Centered on the macula · 2361 by 1568 pixels · acquired with a Kowa VX-10α: 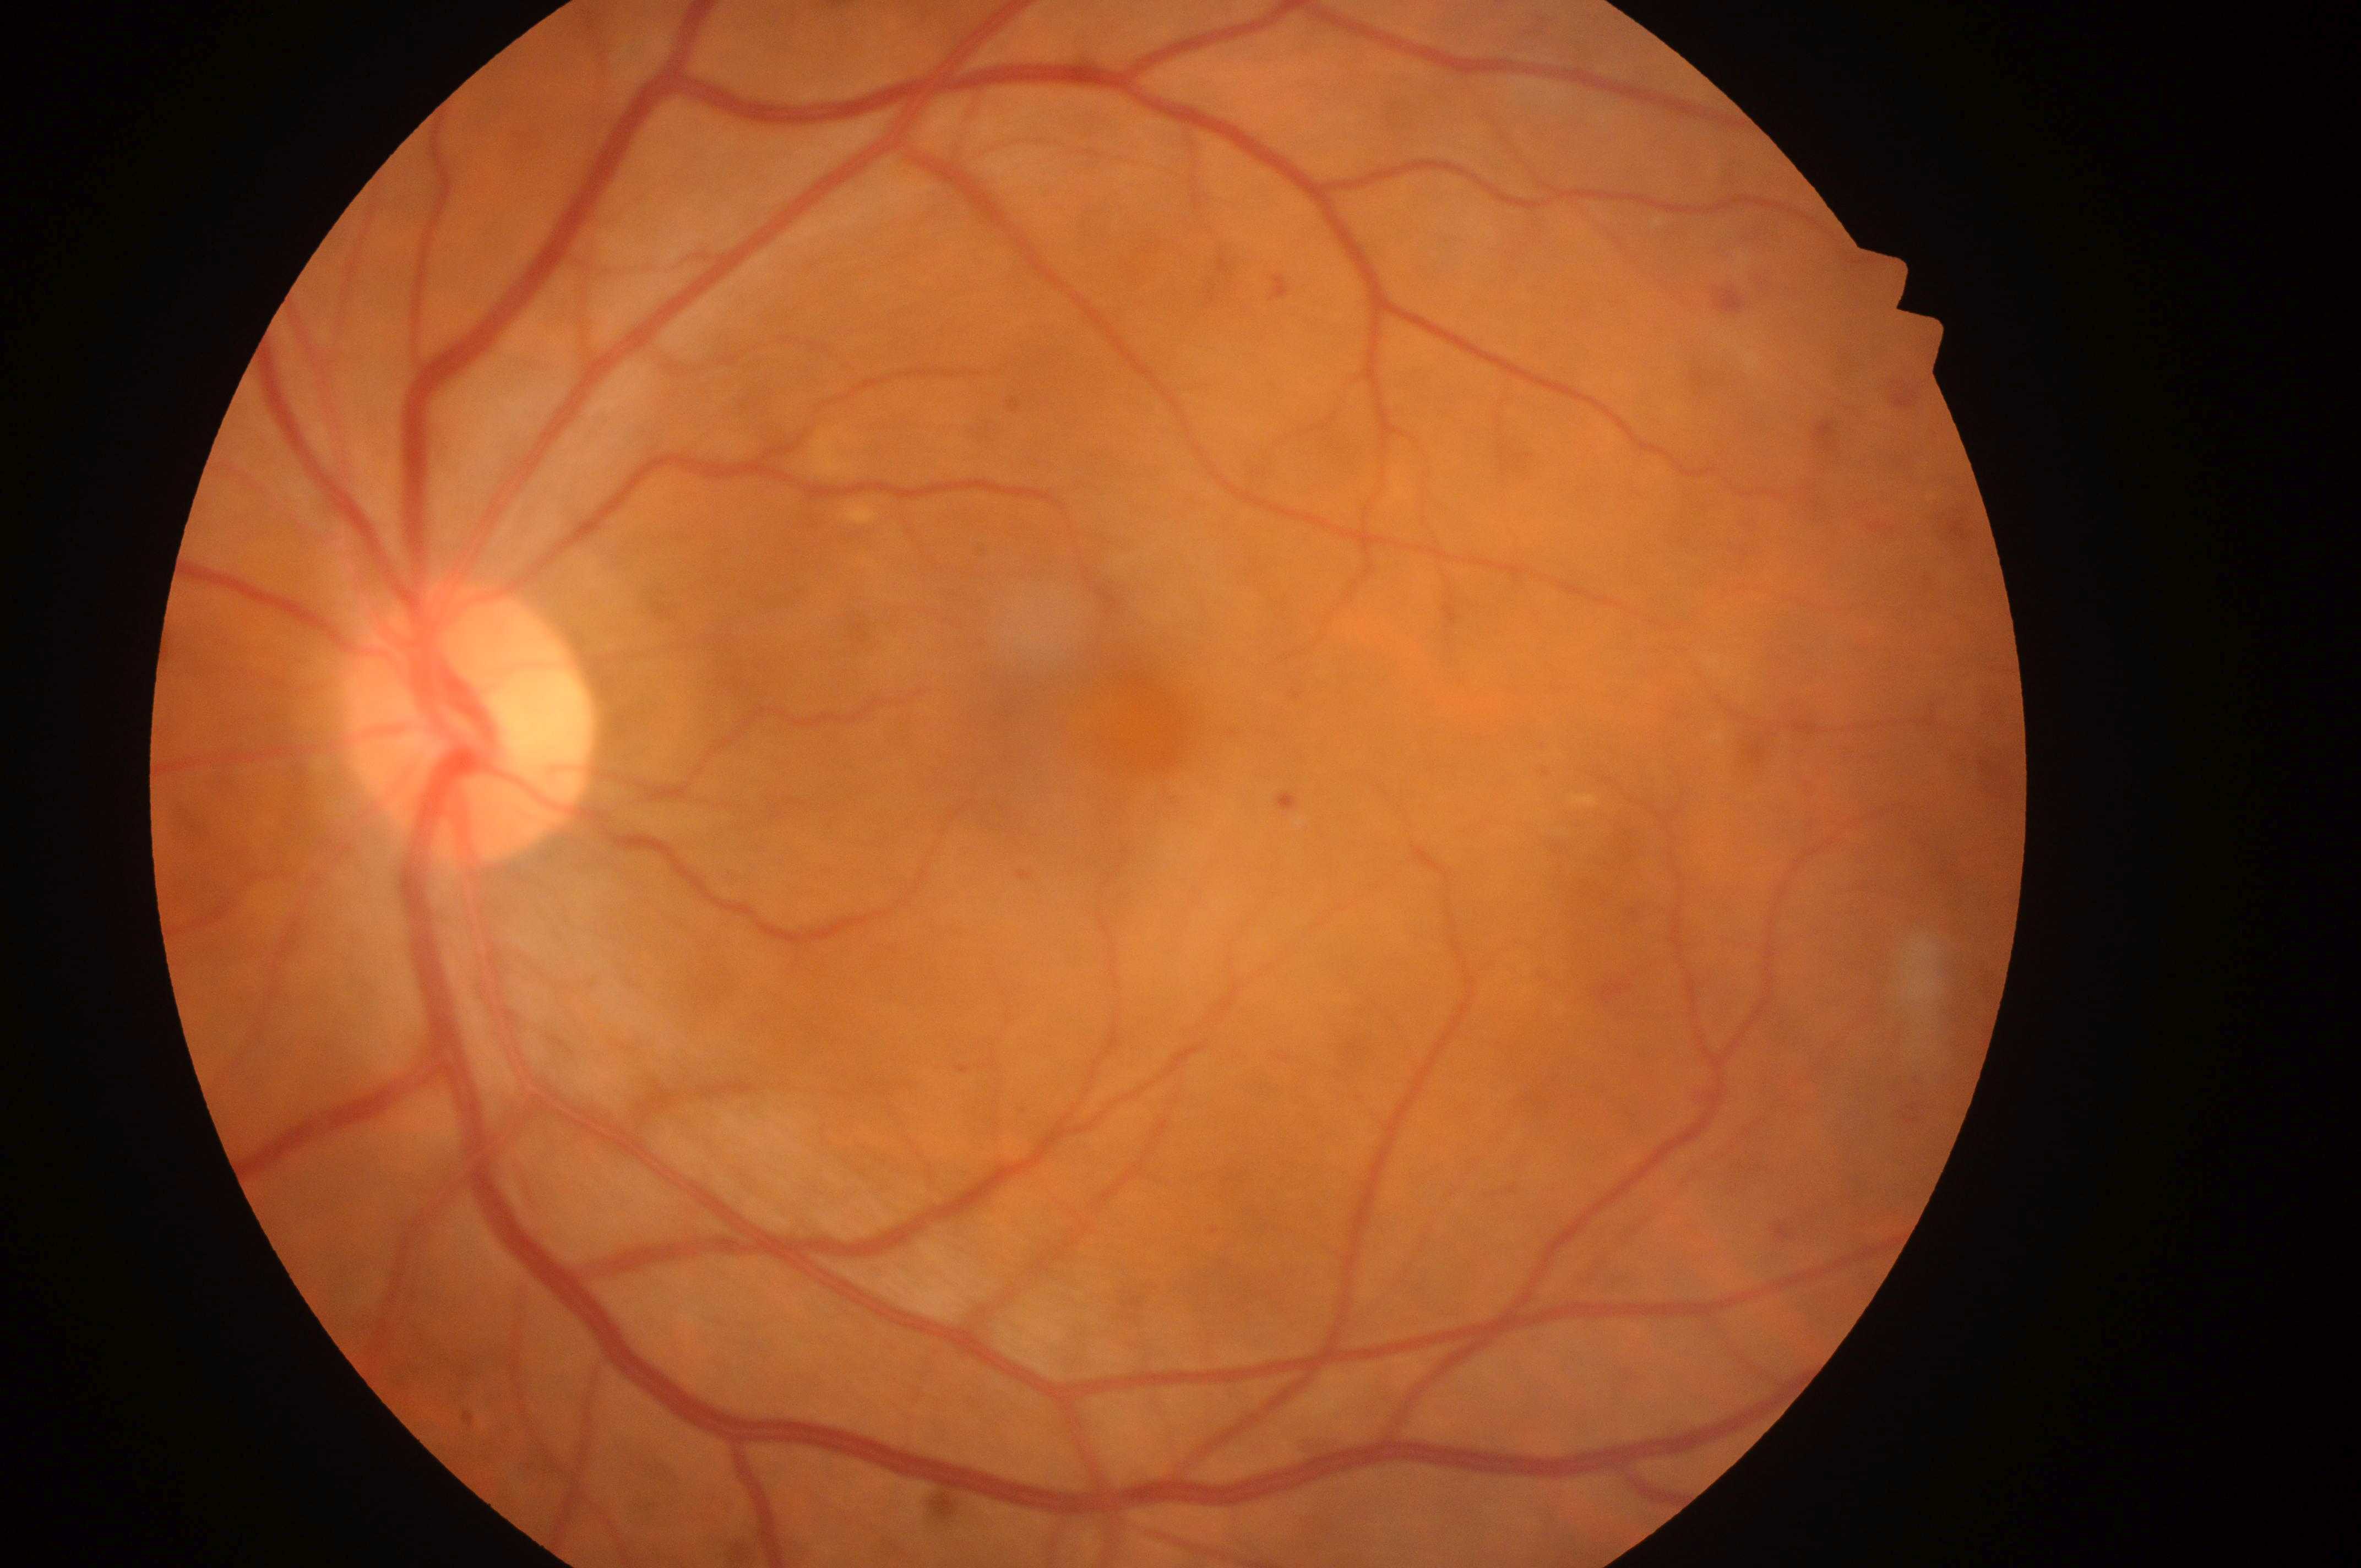 Q: What disease class is present?
A: non-proliferative diabetic retinopathy
Q: Locate the fovea.
A: 1136, 732
Q: Optic disc center?
A: 464, 734
Q: Right or left eye?
A: the left eye
Q: Diabetic retinopathy severity?
A: moderate non-proliferative diabetic retinopathy (grade 2)
Q: Macular edema risk?
A: grade 0 (no risk)